Diabetic retinopathy graded by the modified Davis classification — 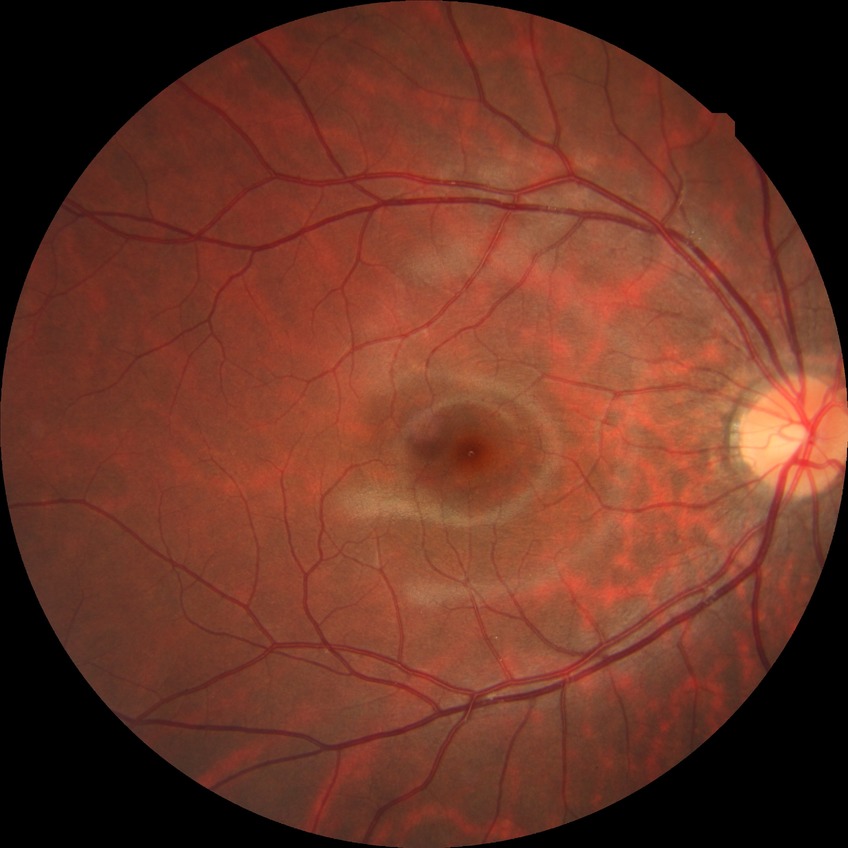 Diabetic retinopathy (DR) is no diabetic retinopathy (NDR).